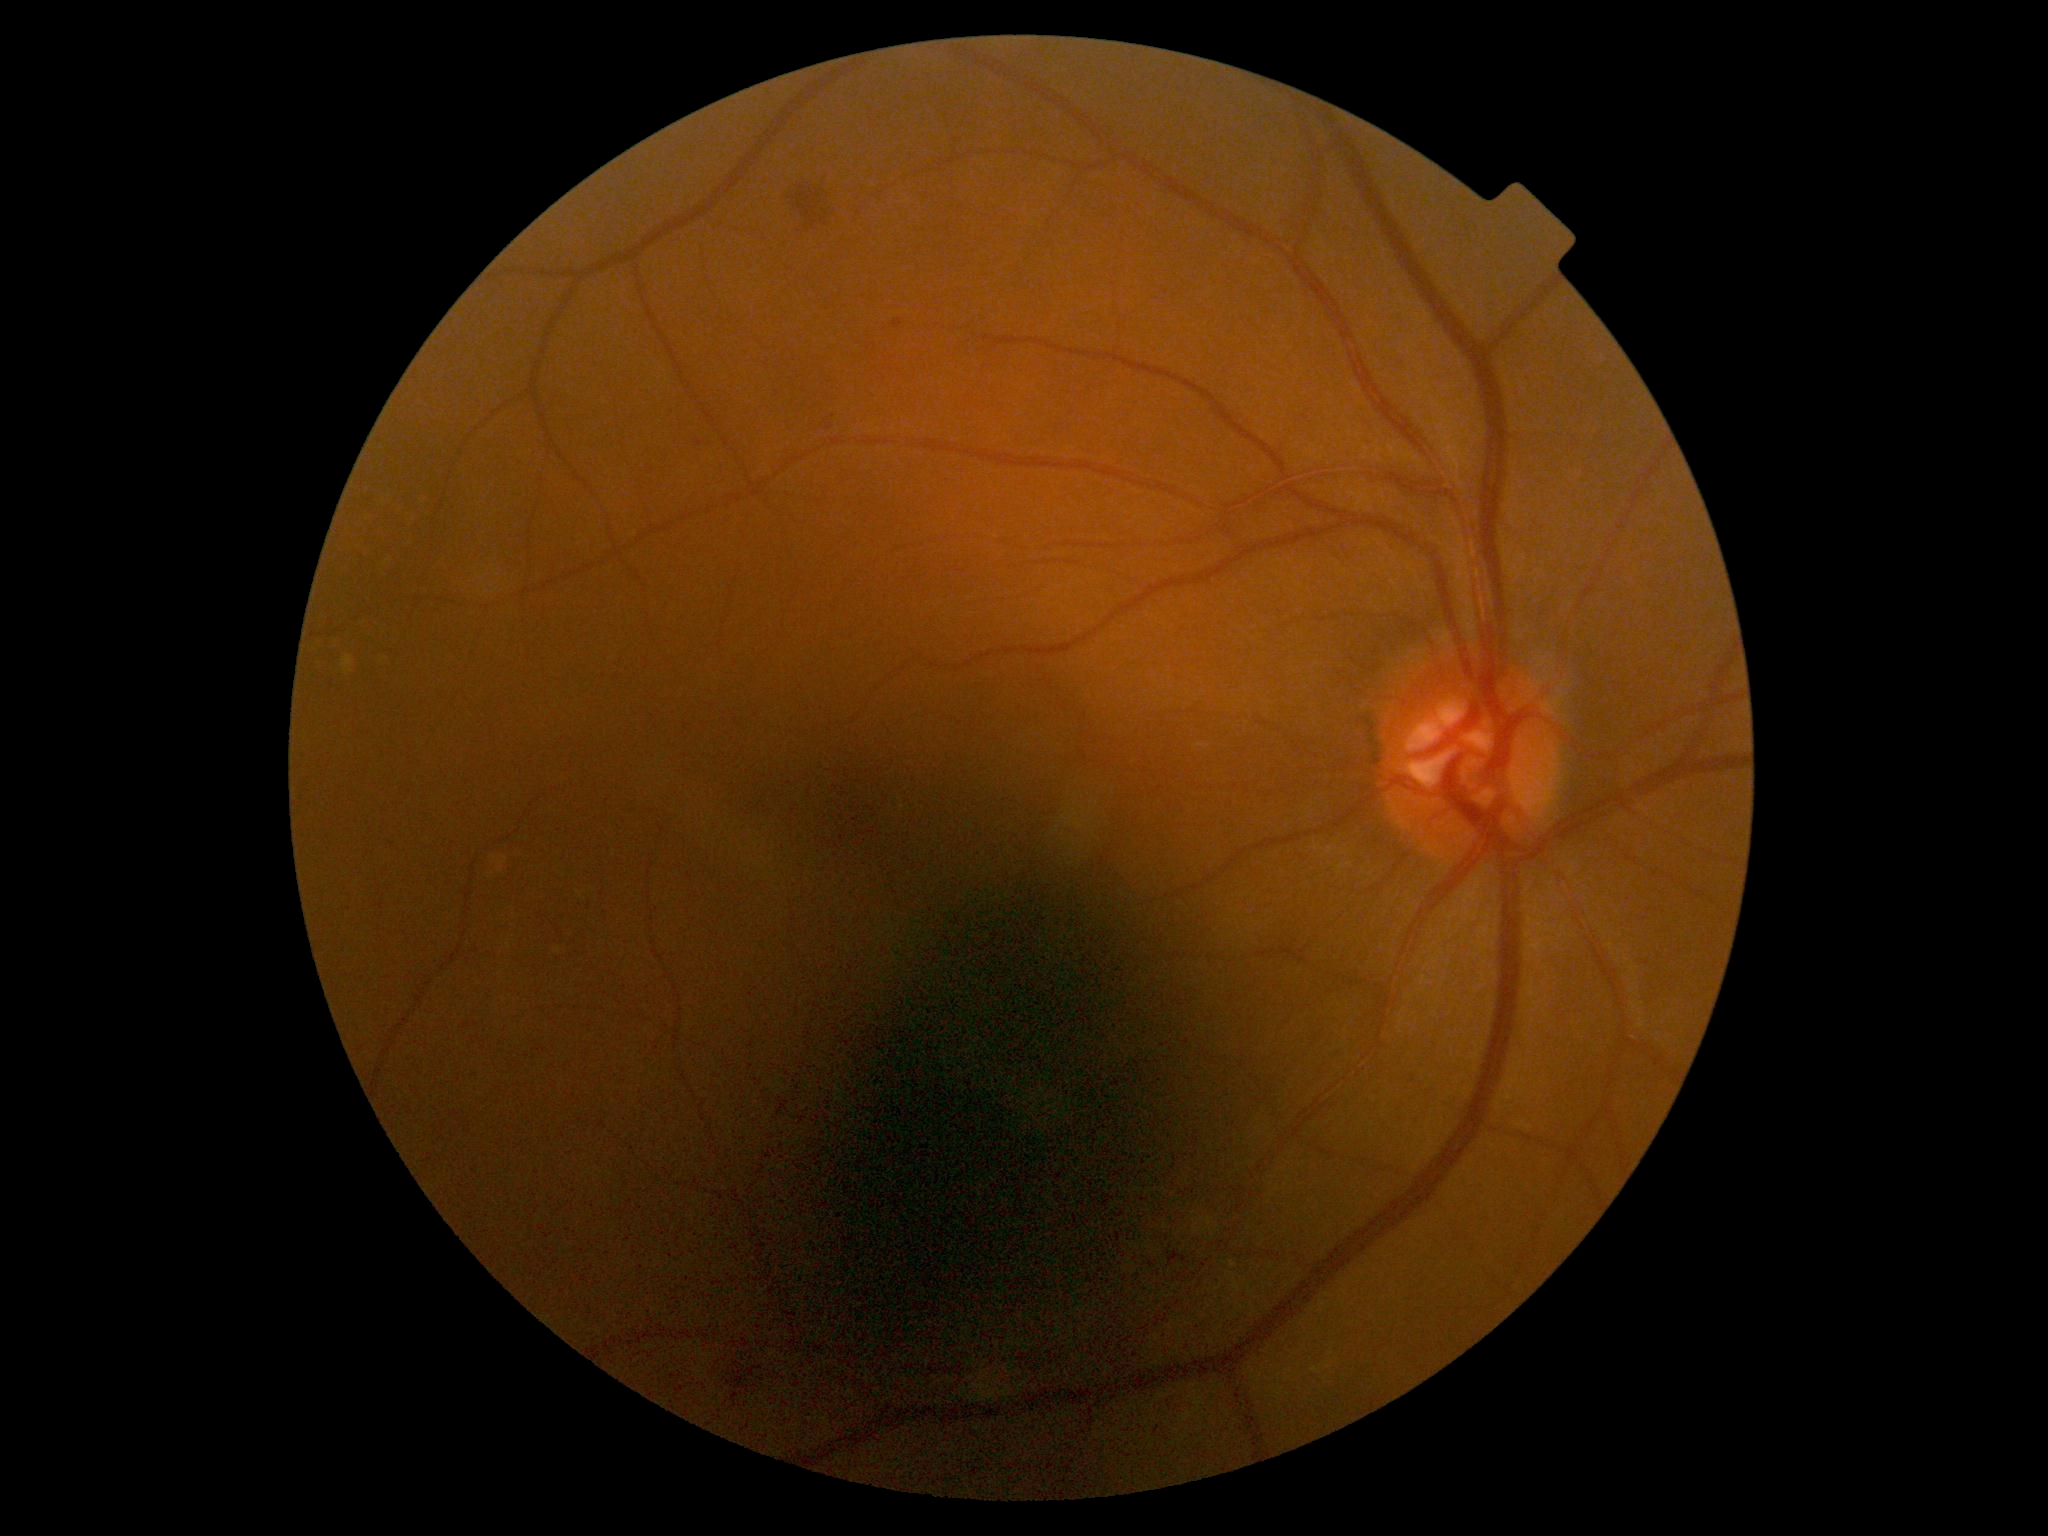
DR grade is 2 (moderate NPDR) — more than just microaneurysms but less than severe NPDR.